Color fundus photograph, FOV: 45 degrees.
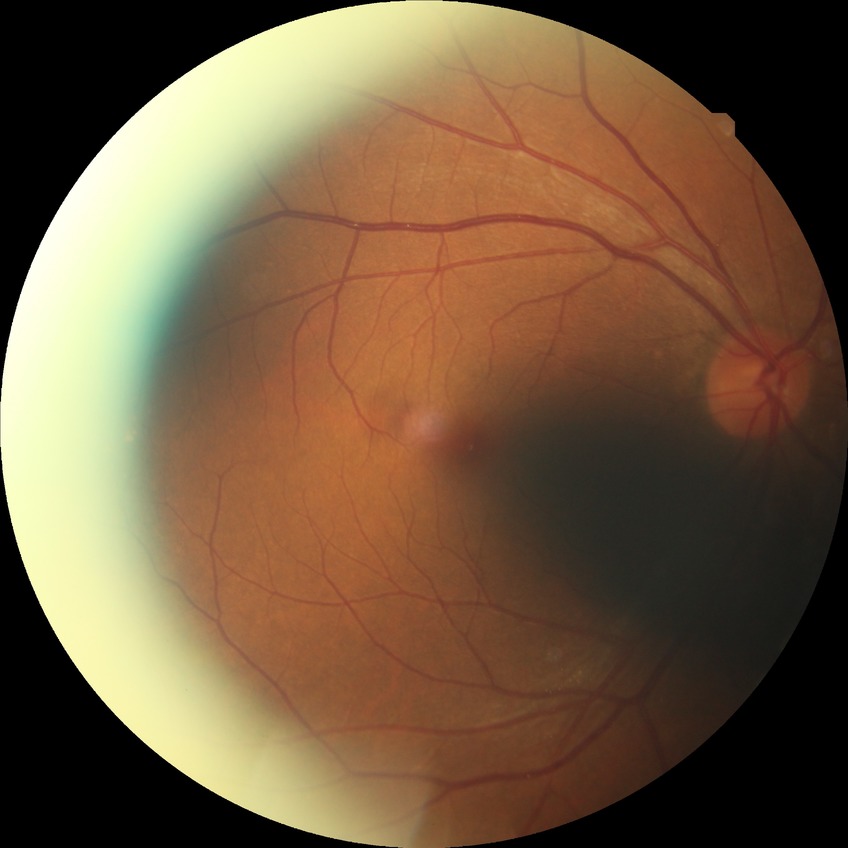

Diabetic retinopathy (DR): no diabetic retinopathy (NDR).